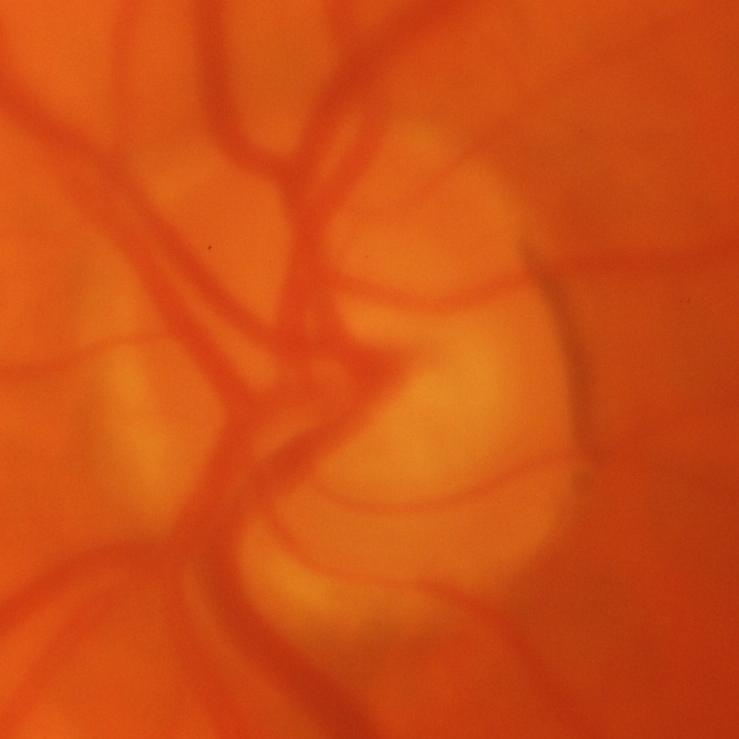
Glaucoma.